Modified Davis classification:
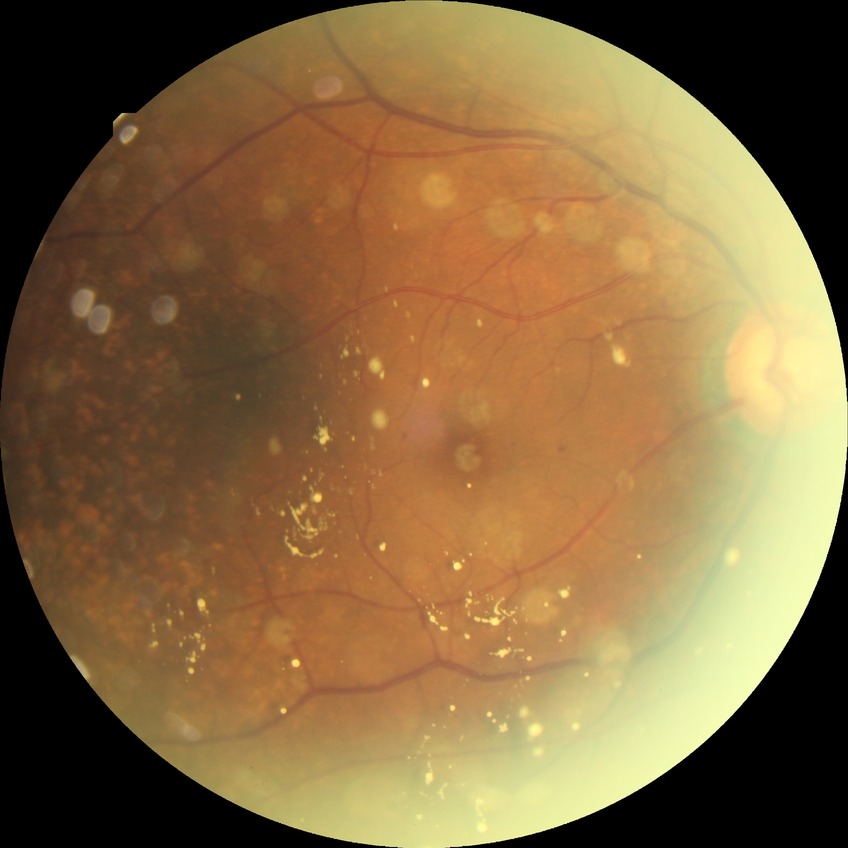
retinopathy grade=simple diabetic retinopathy.